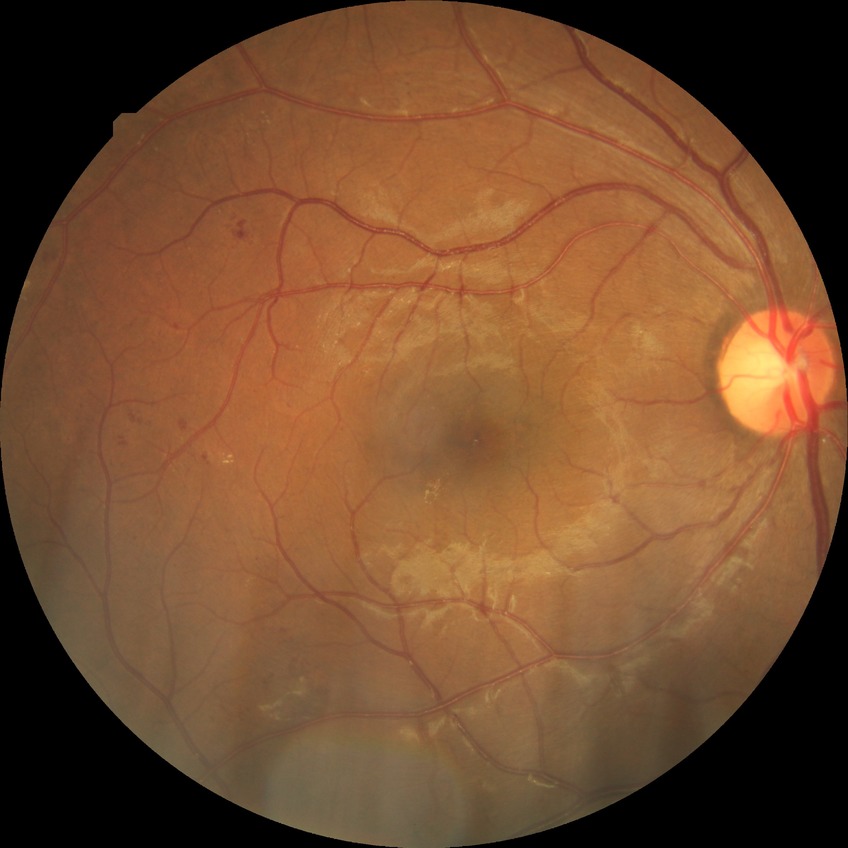
Modified Davis grade: SDR. The retinopathy is classified as non-proliferative diabetic retinopathy.